2352x1568. Color fundus photograph:
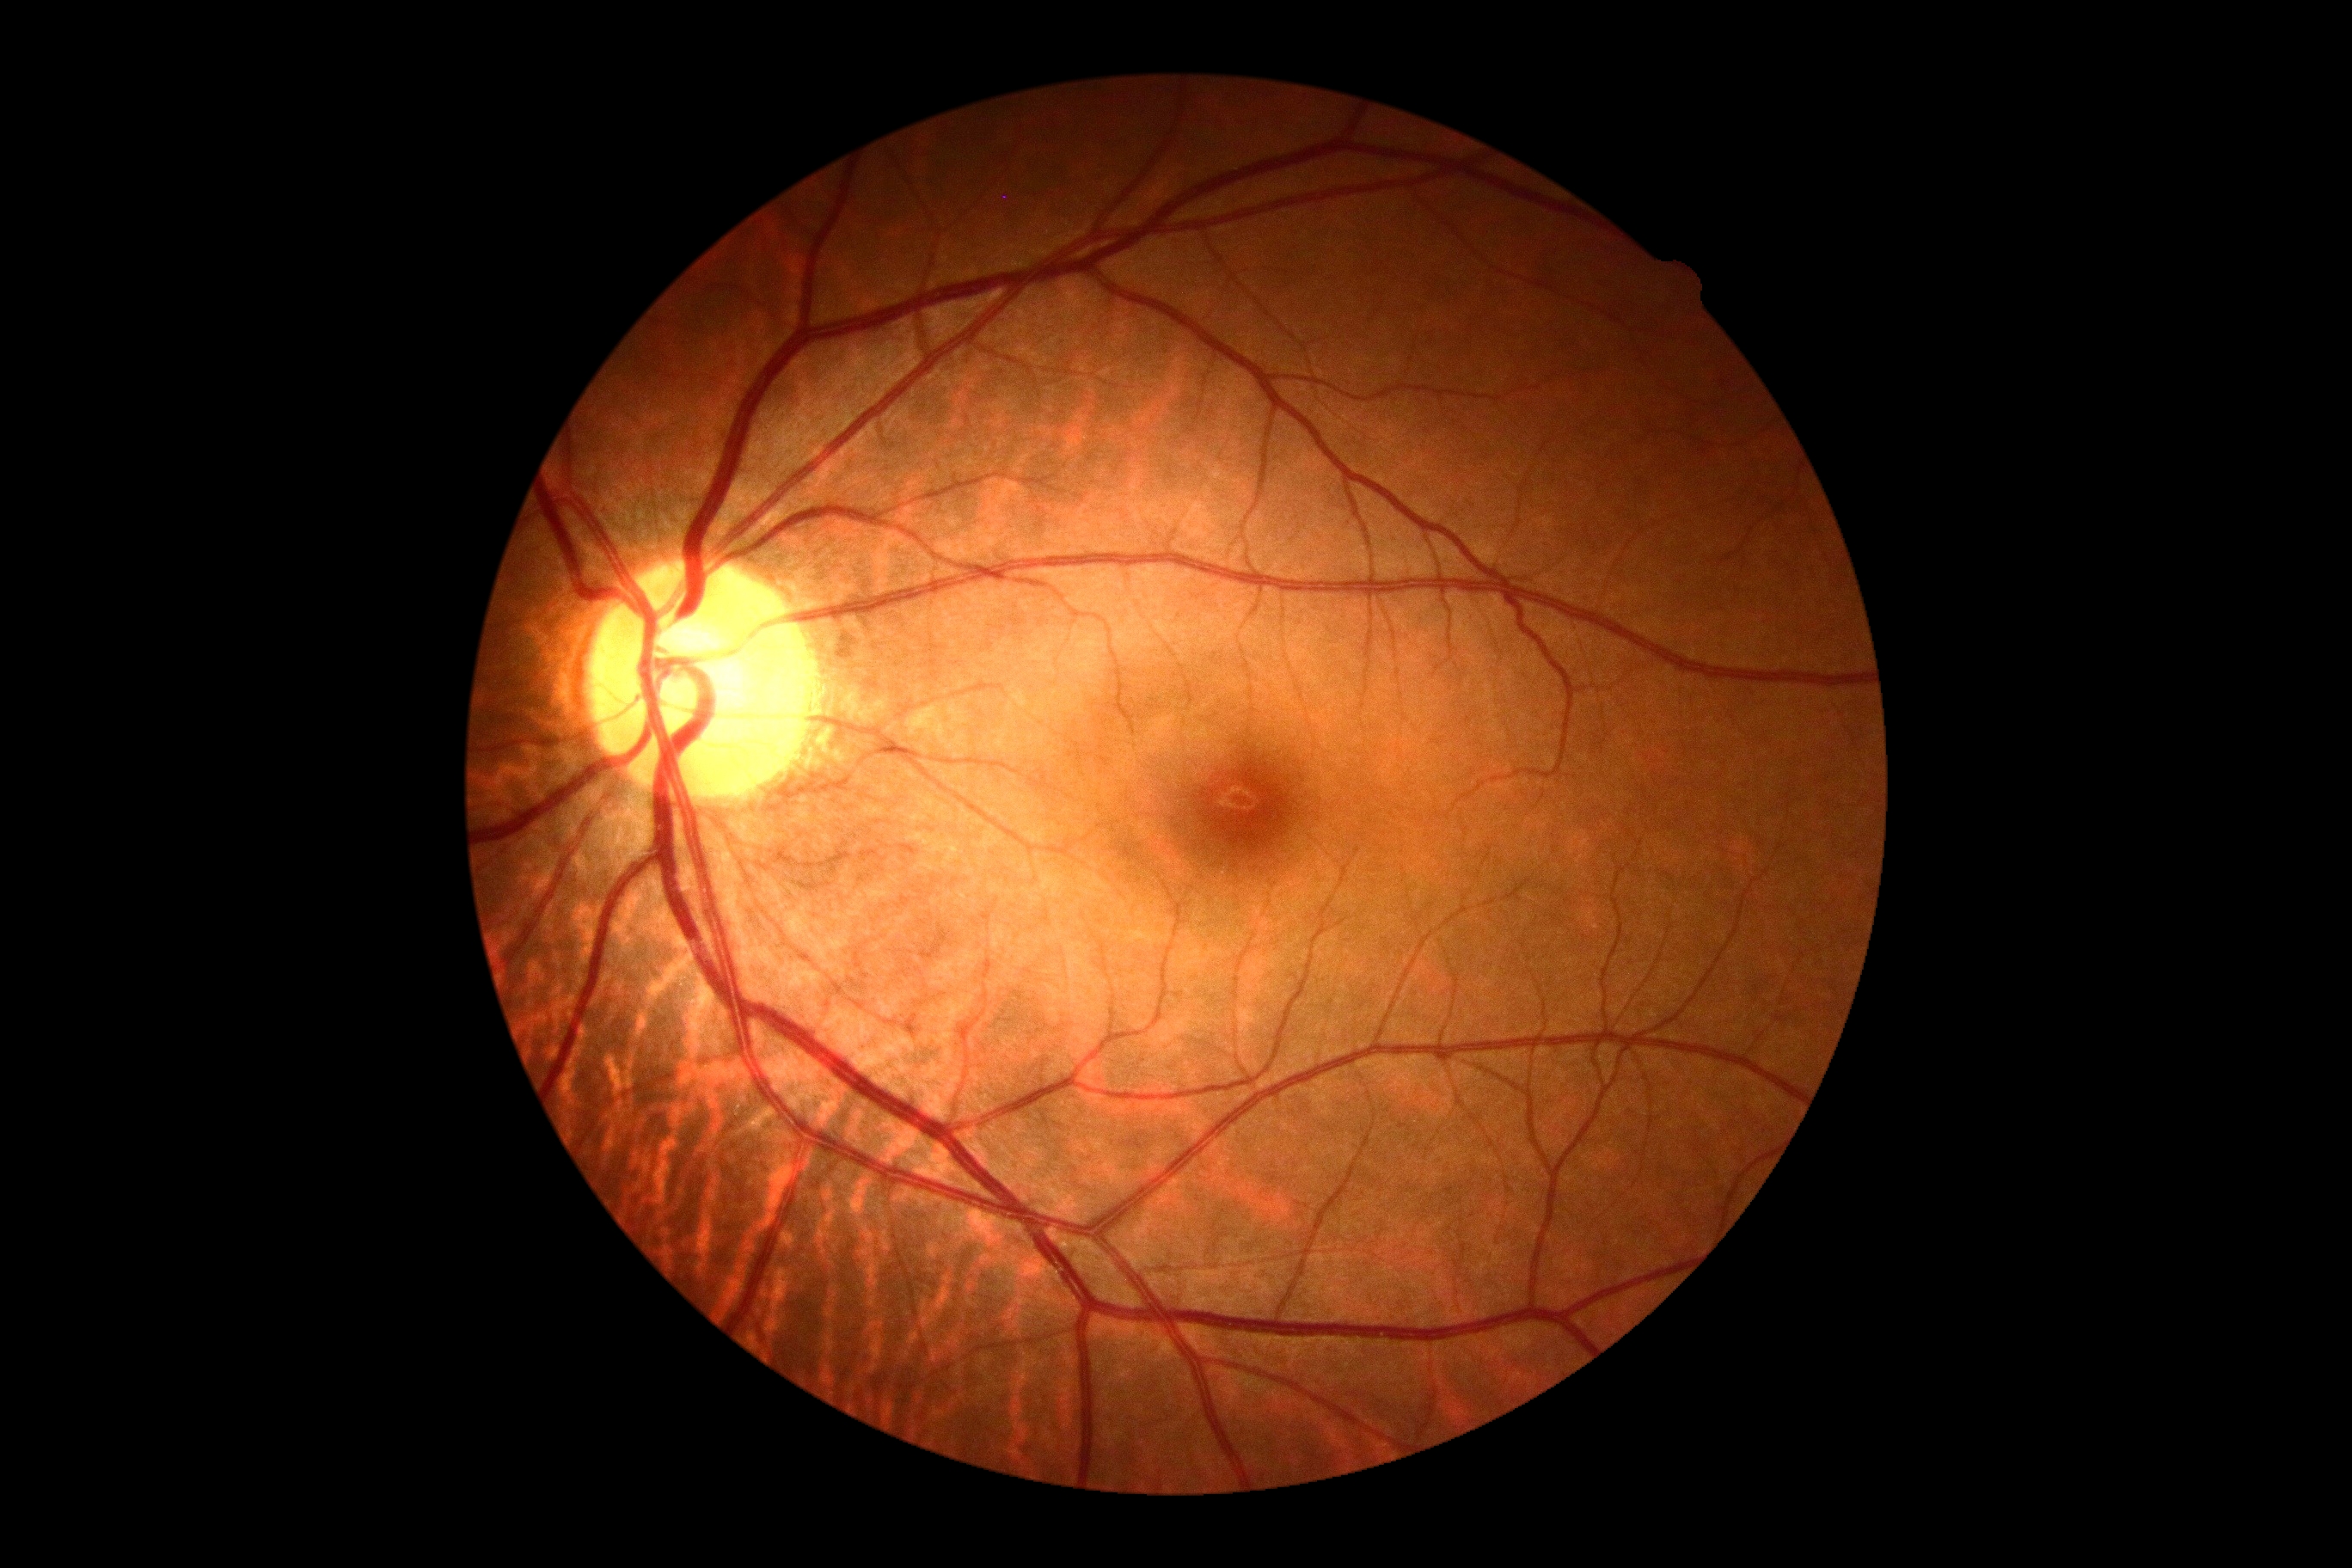 Annotations:
- DR stage: 0/4